Fundus photo; 45° field of view; 2352x1568:
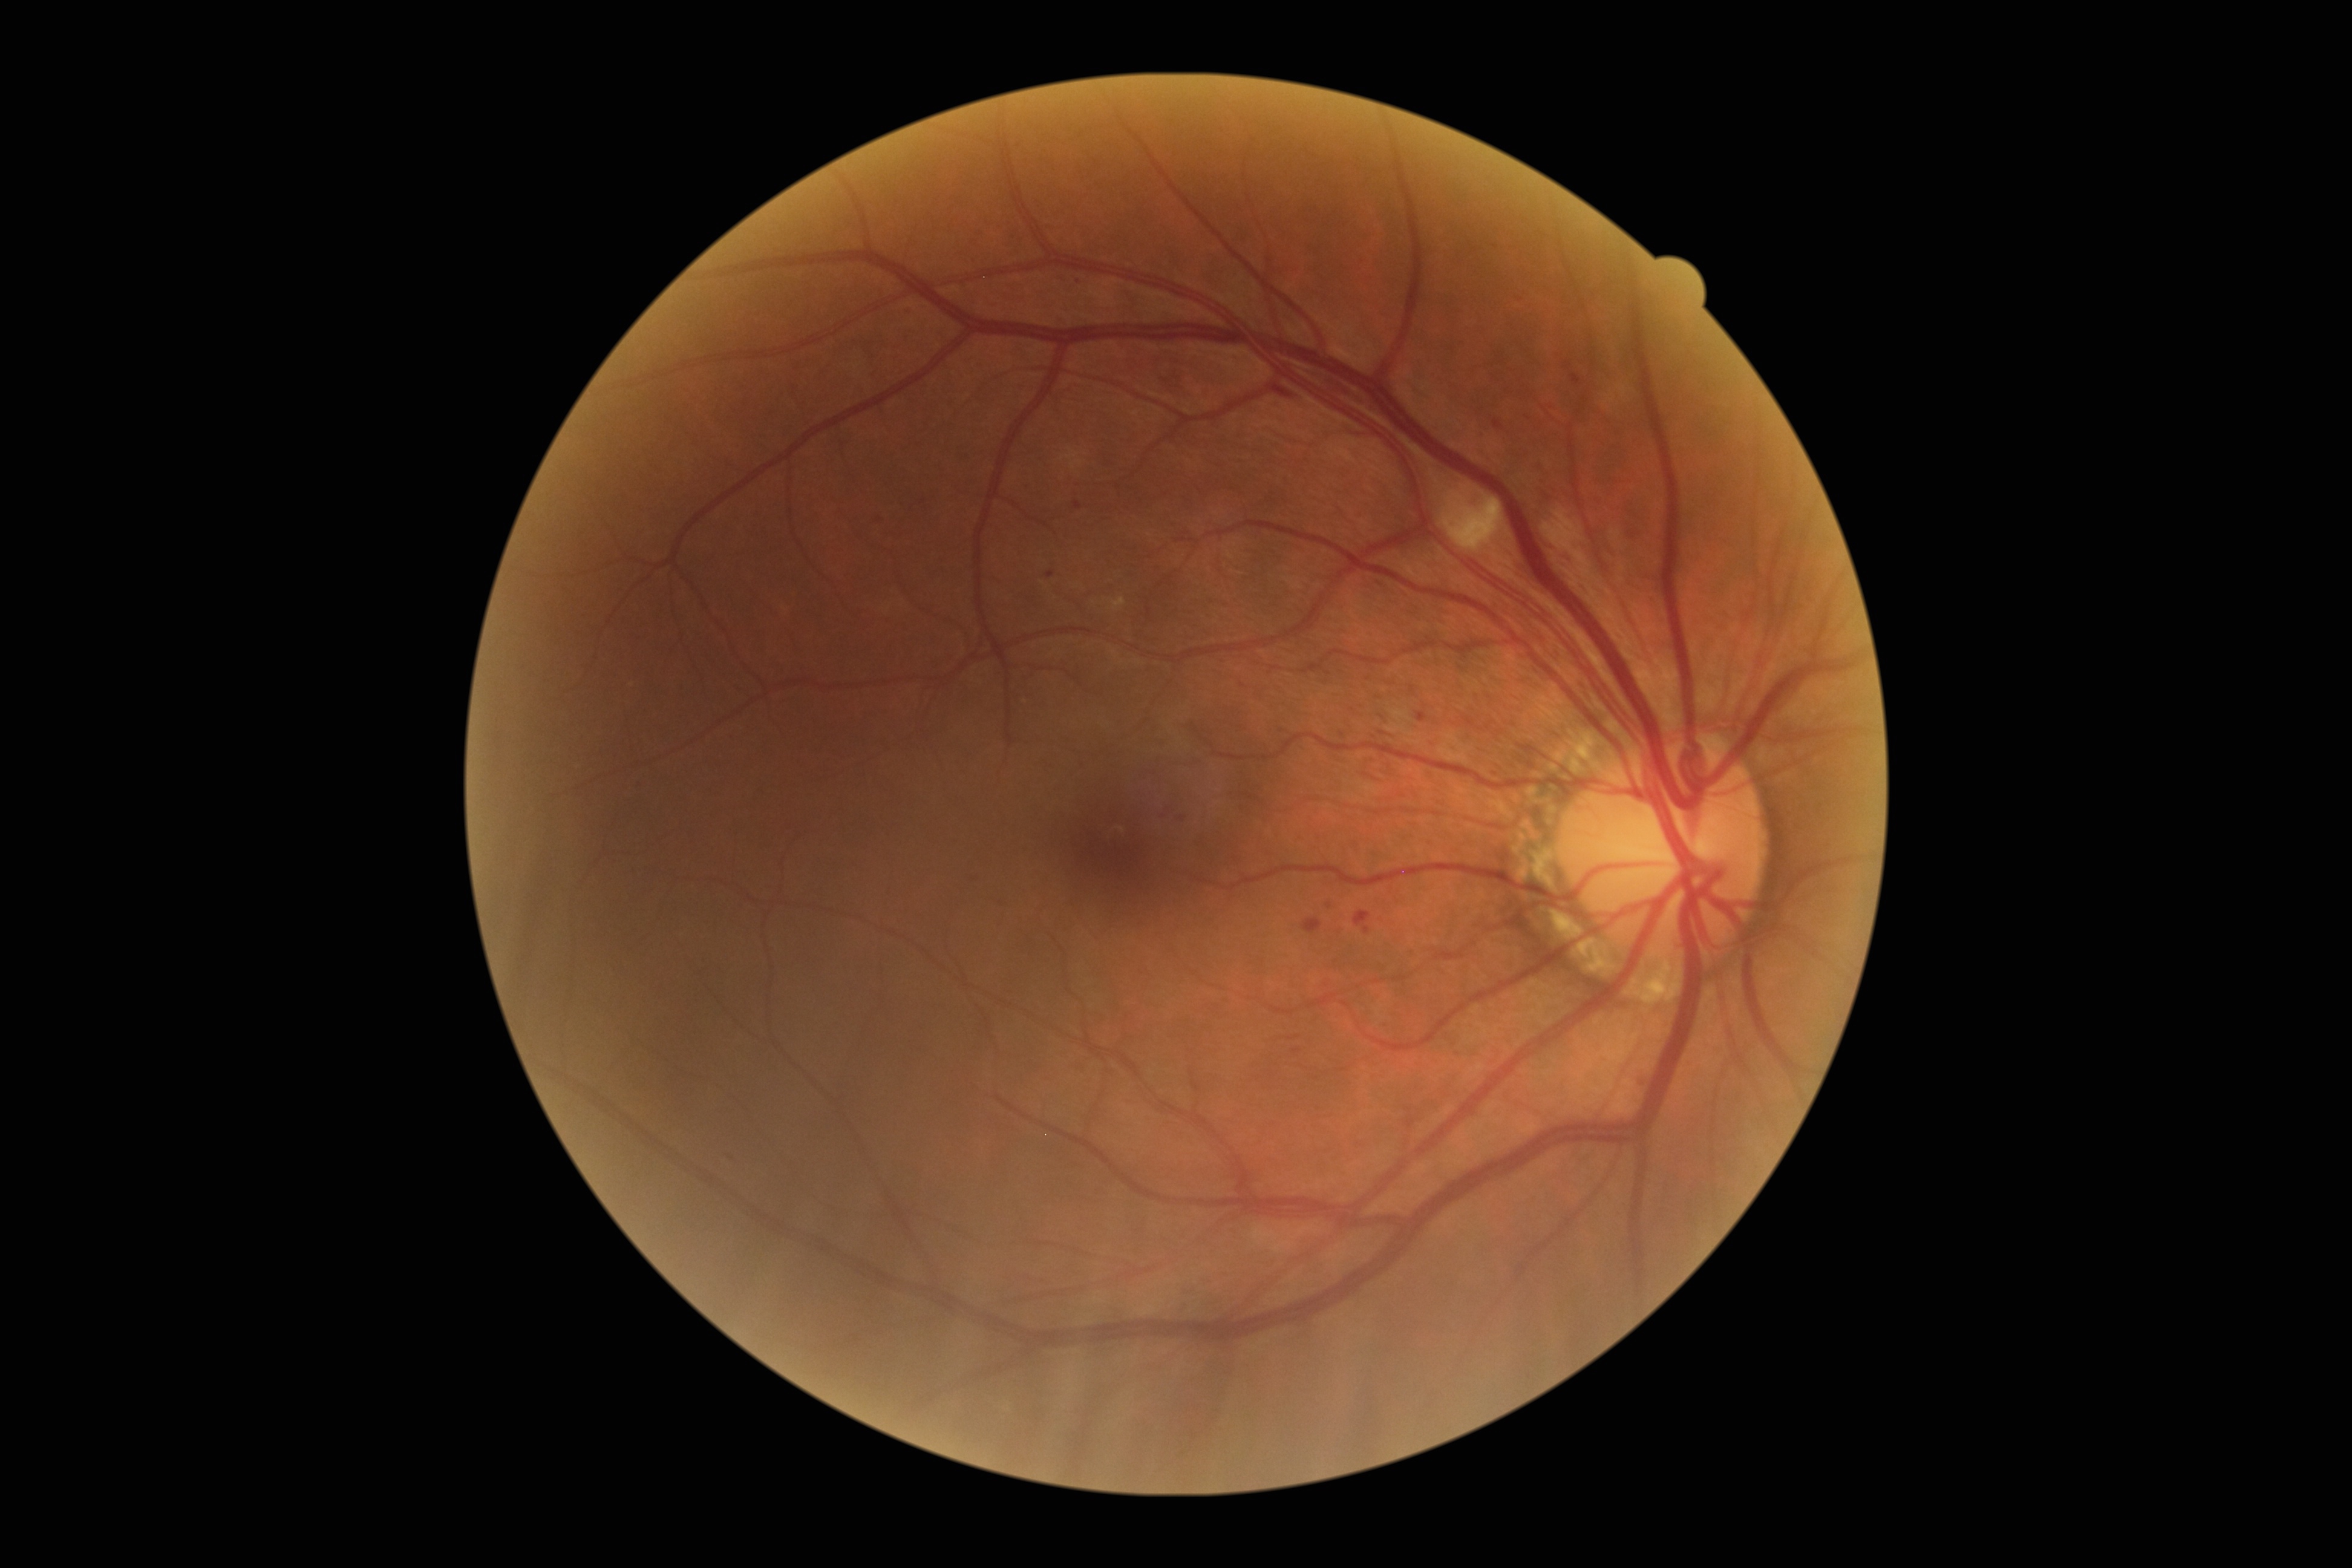 DR grade is 2 (moderate NPDR).